Infant wide-field retinal image. Acquired on the Clarity RetCam 3.
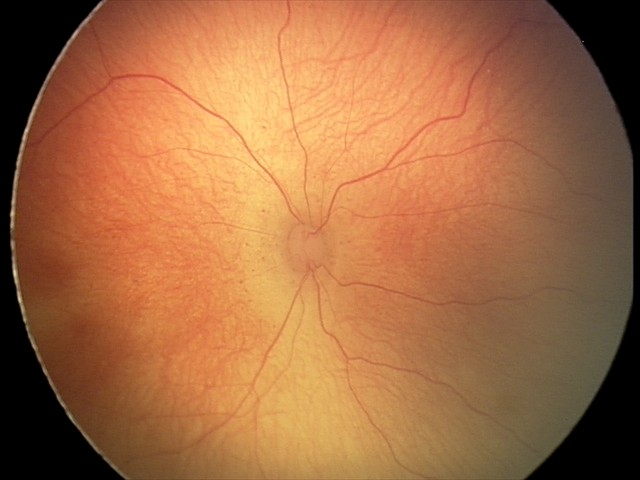
Impression: retinopathy of prematurity (ROP) stage 2 — ridge with height and width at the demarcation line | no plus disease.